2089 x 1764 pixels: 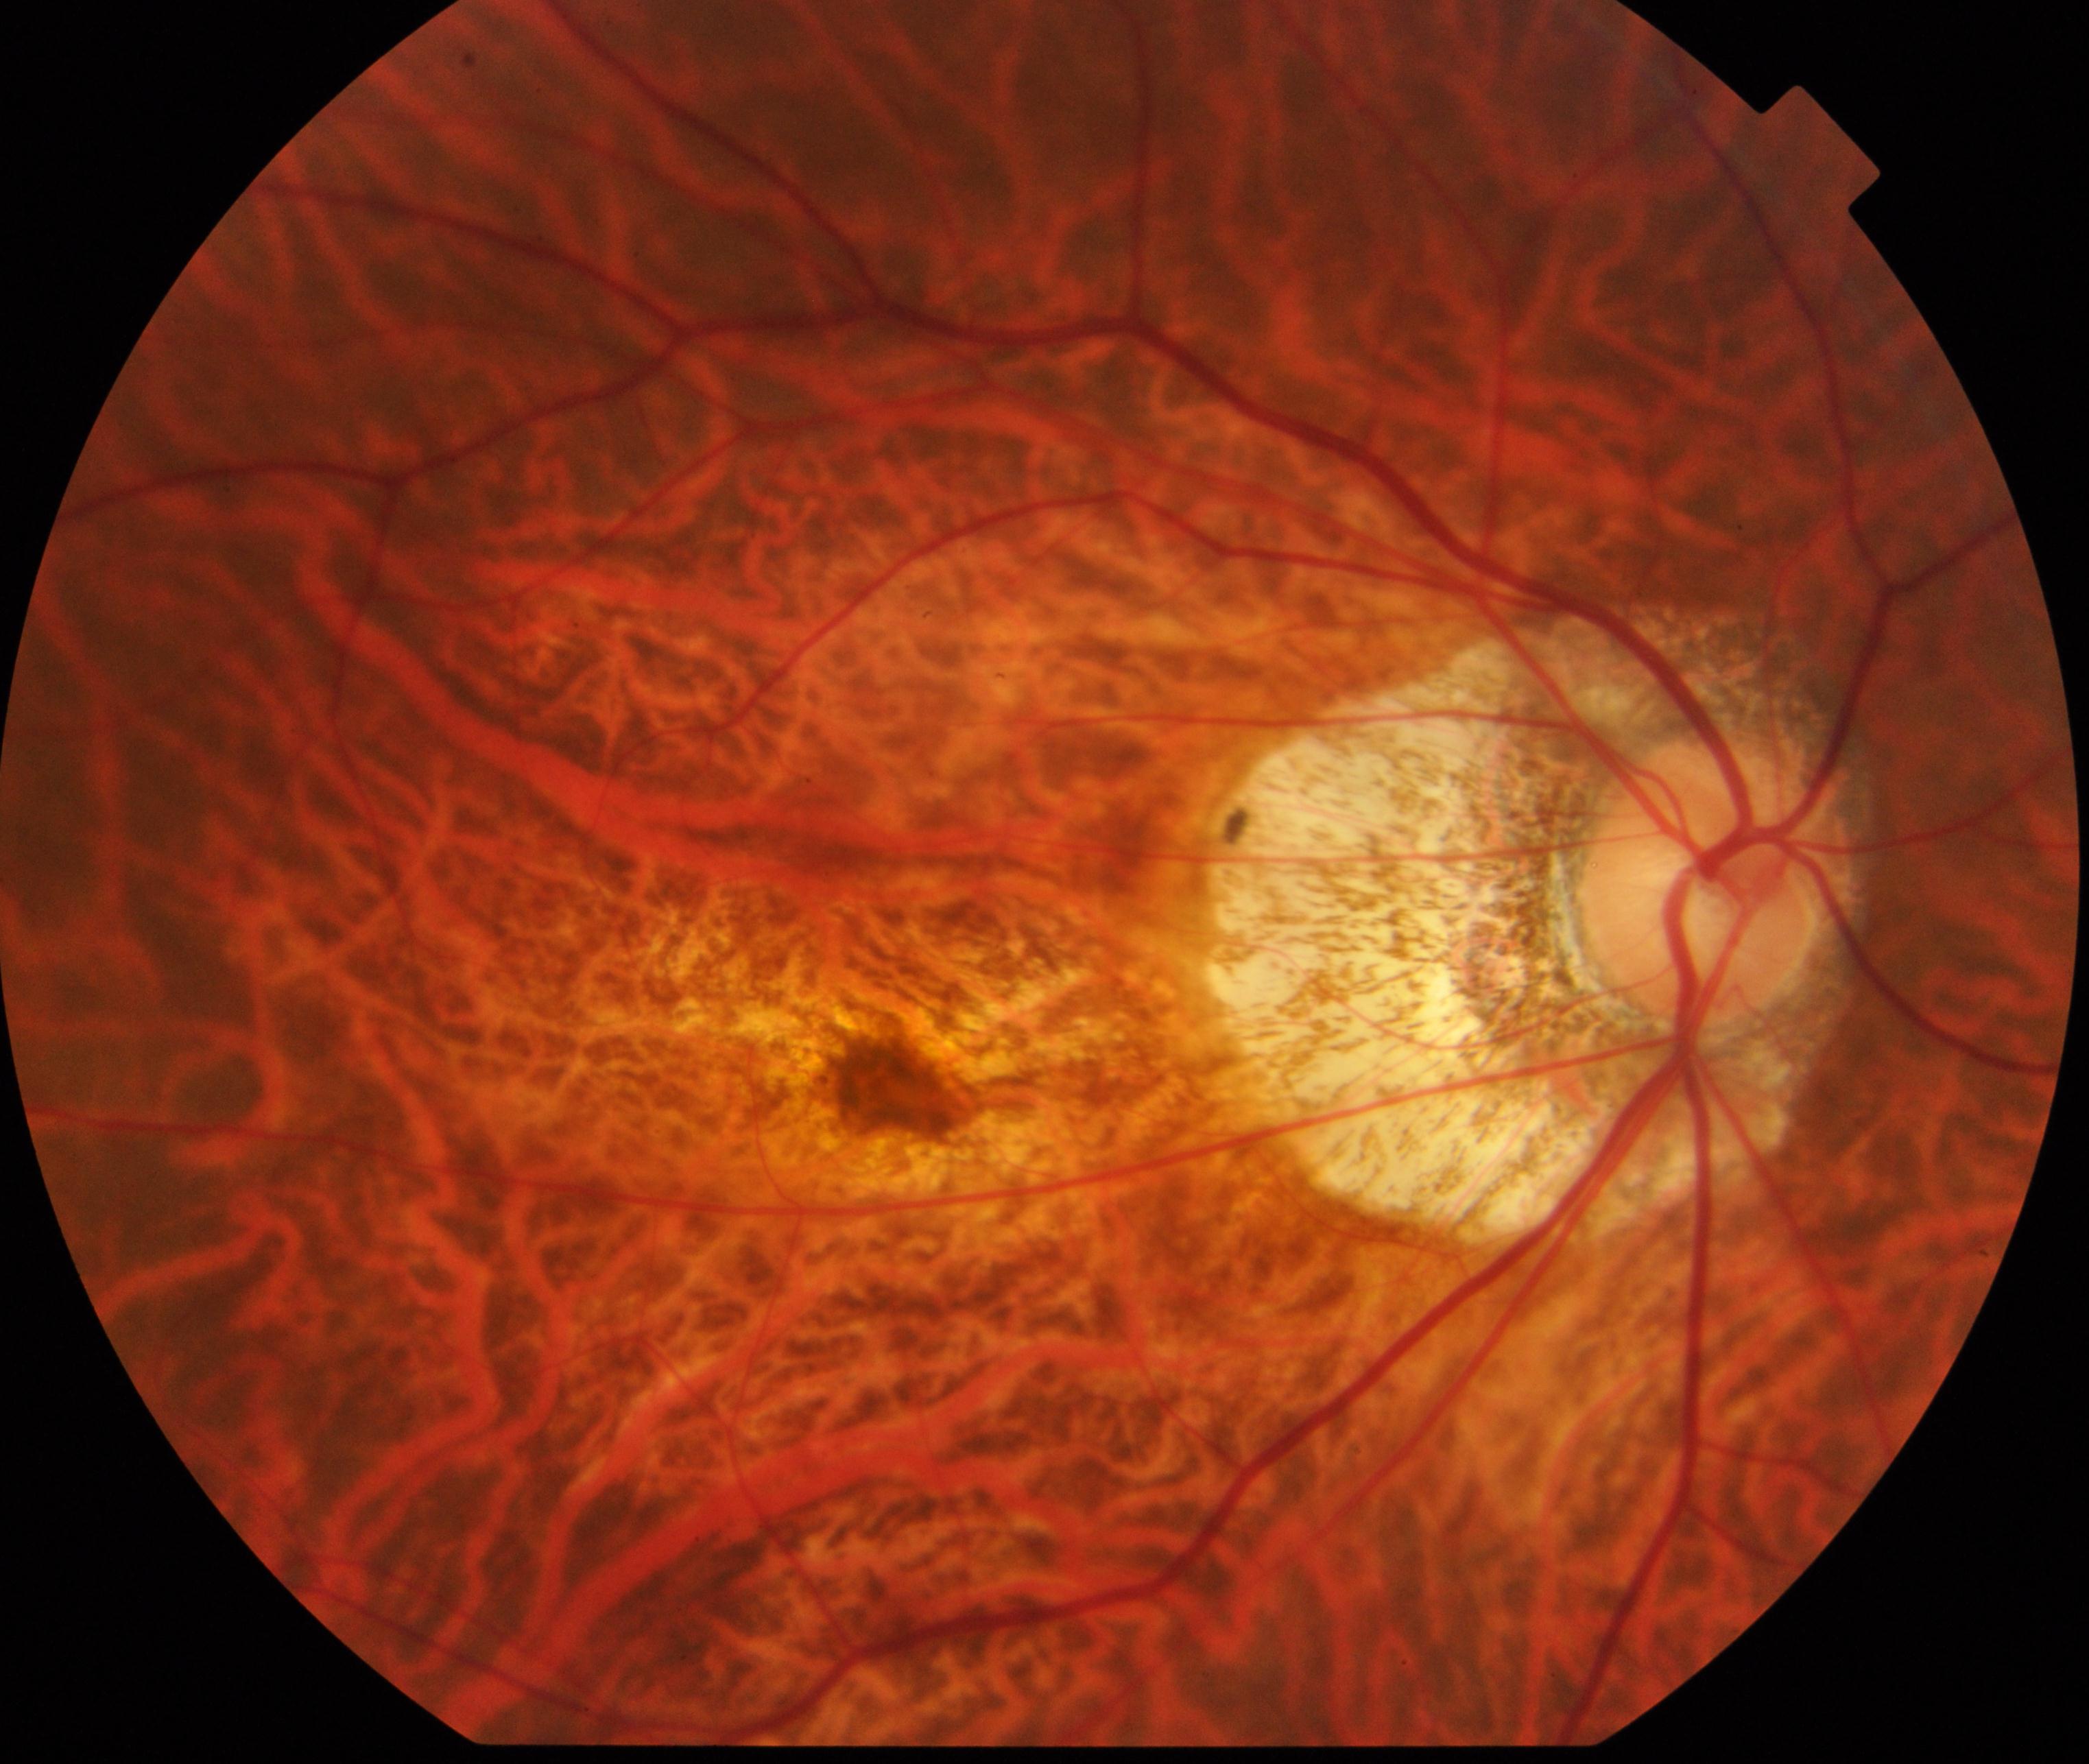
Appearance consistent with pathological myopia. Typically showing tessellated fundus with focal chorioretinal atrophy, Fuchs spot, lacquer cracks, choroidal neovascularization, or subretinal hemorrhage.